Wide-field fundus photograph from neonatal ROP screening: 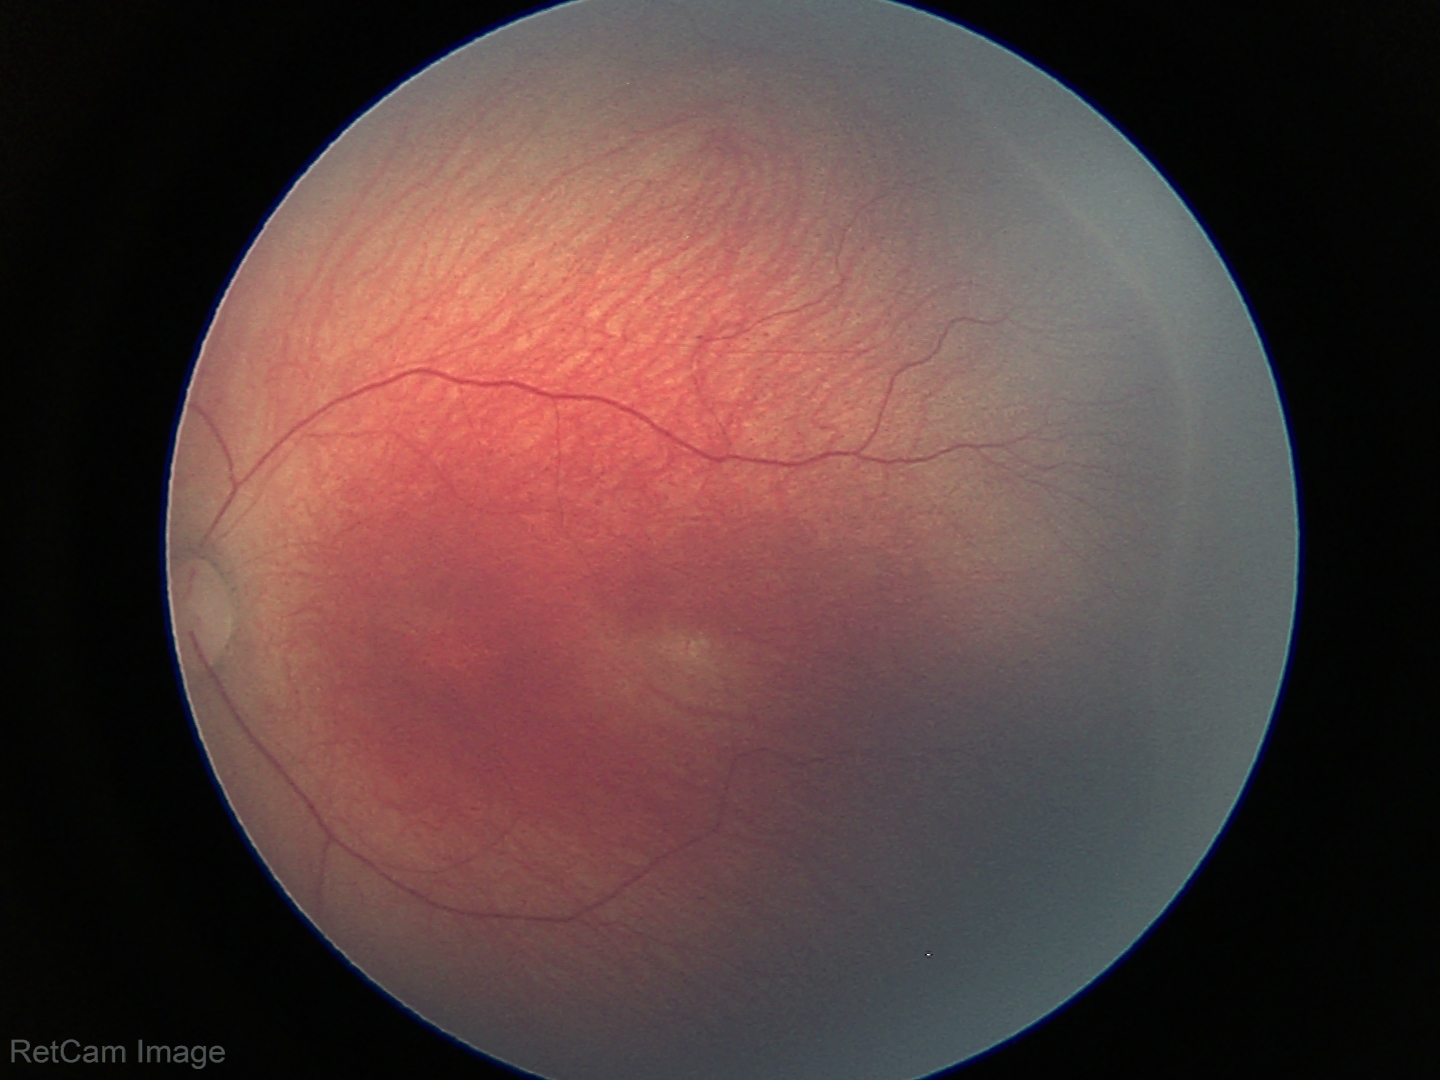 Plus form = absent — posterior pole vessels without abnormal dilation or tortuosity, ROP stage = 2.